CFP: 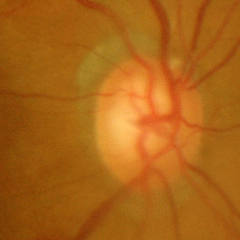

Optic disc appearance consistent with advanced-stage glaucoma.